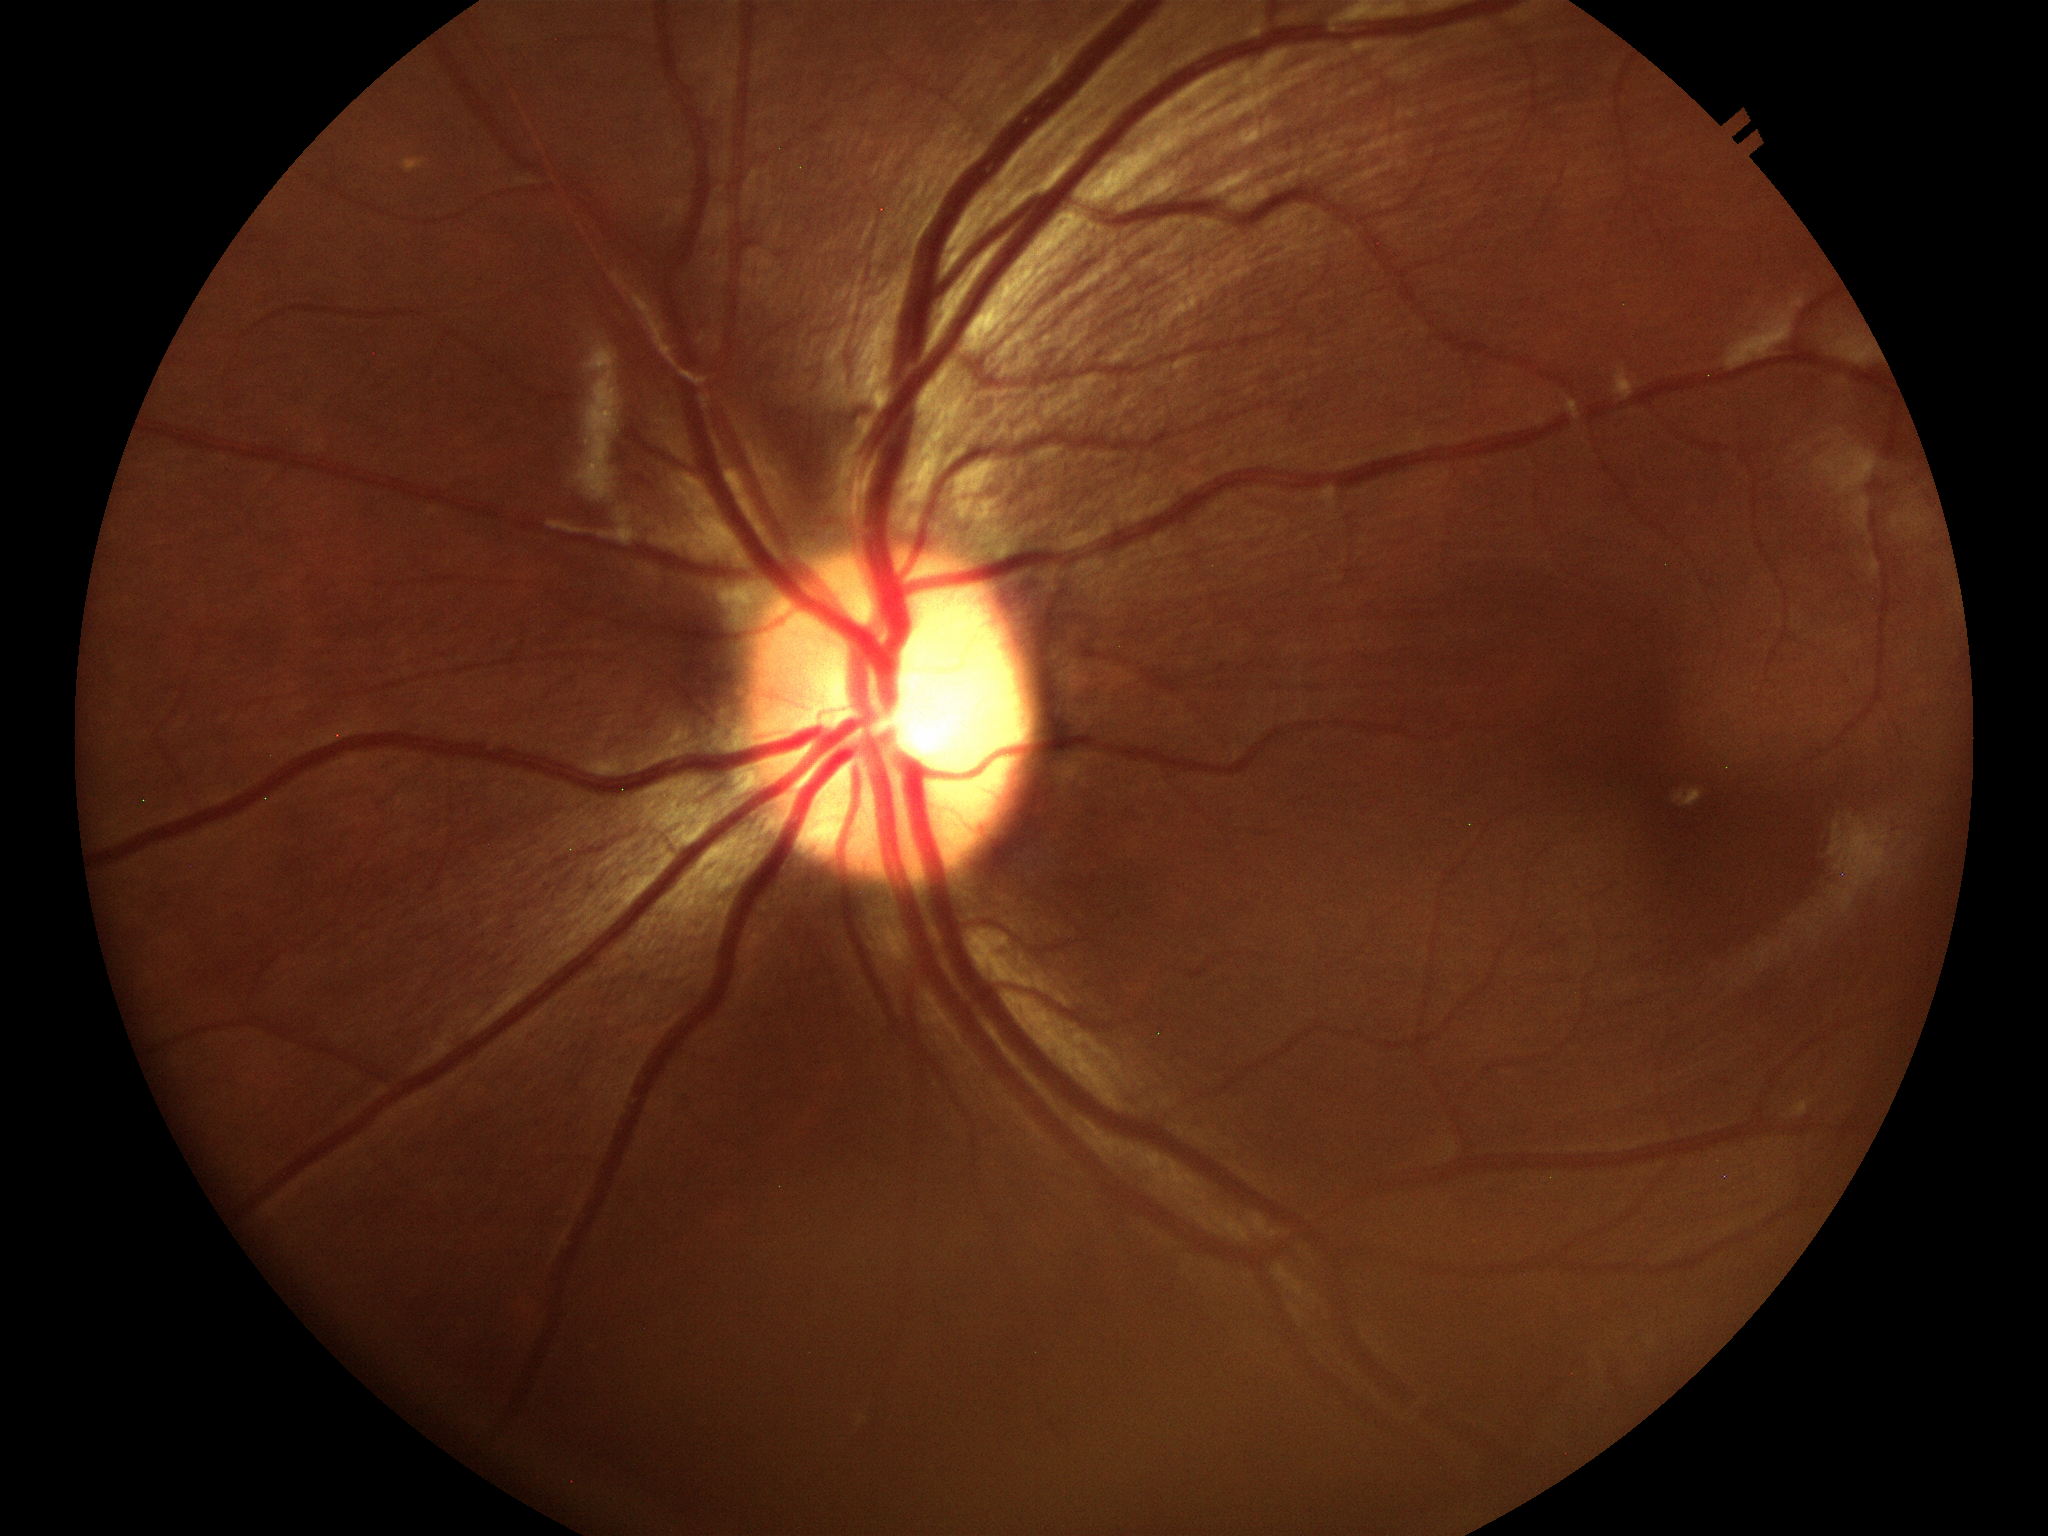
Glaucoma screening: not suspect
vertical C/D ratio (VCDR): 0.60
horizontal CDR (HCDR): 0.58